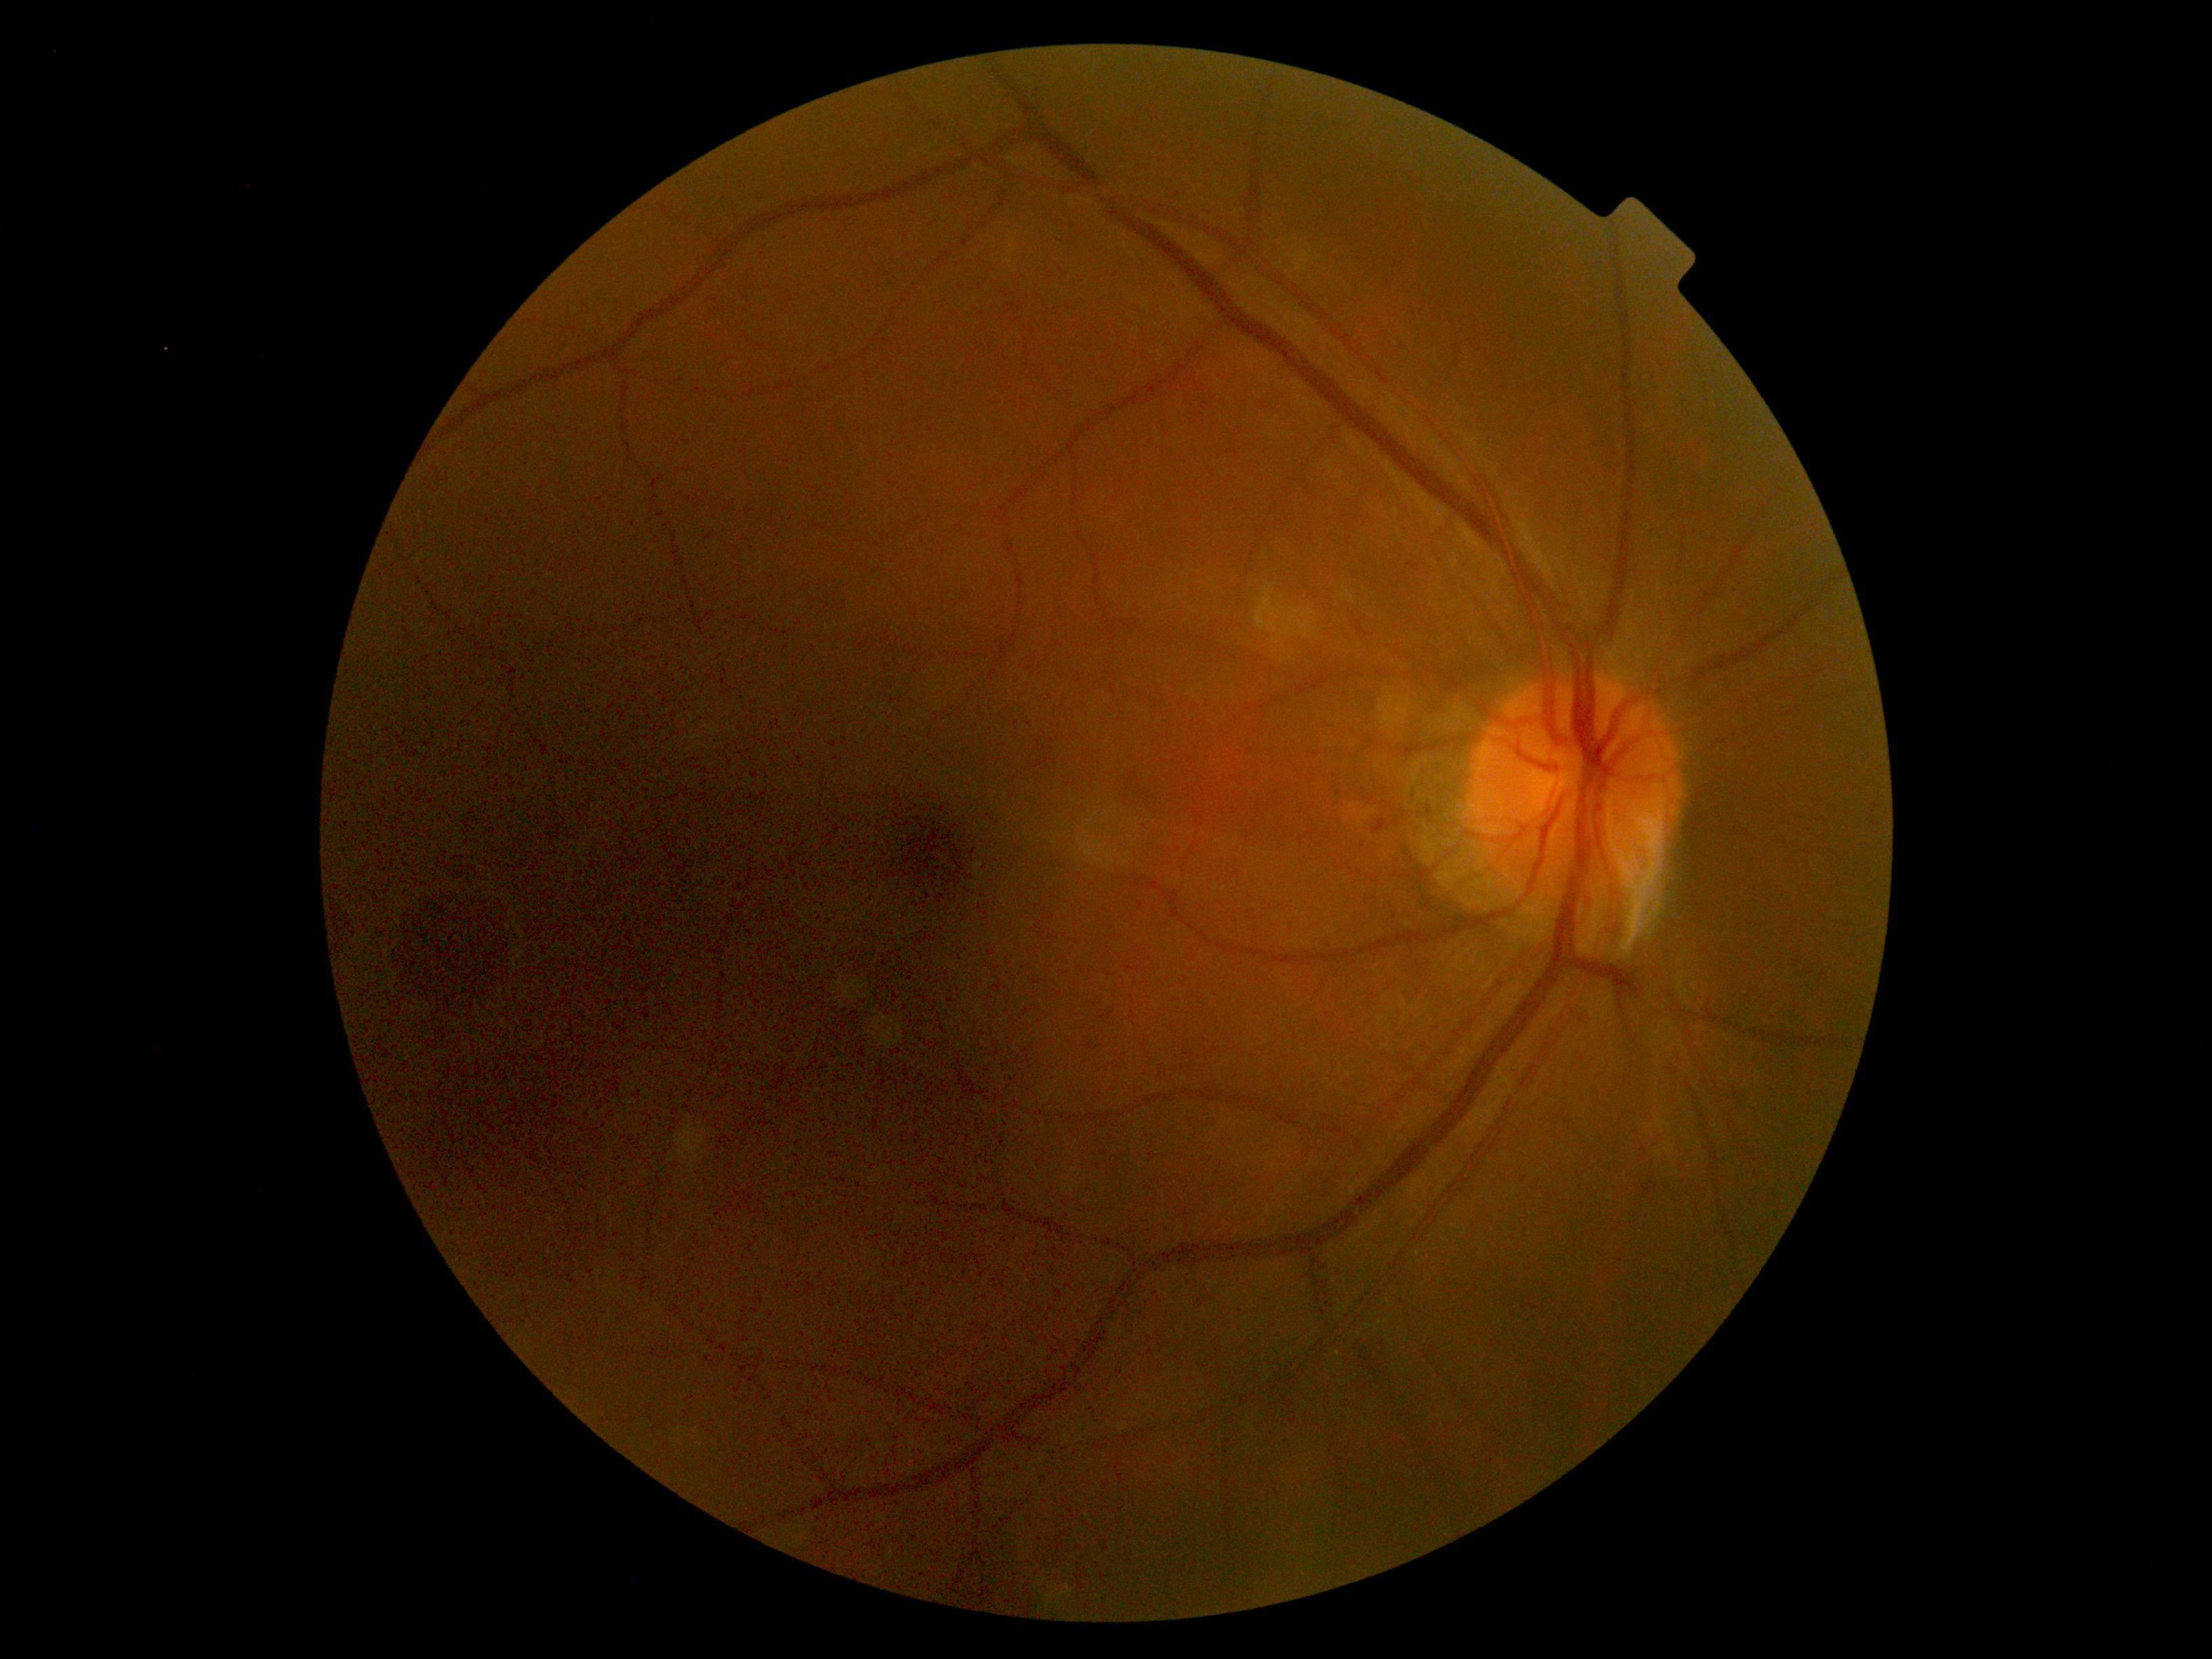 Retinopathy: 2/4.